Image size 1932x1910; 45-degree field of view — 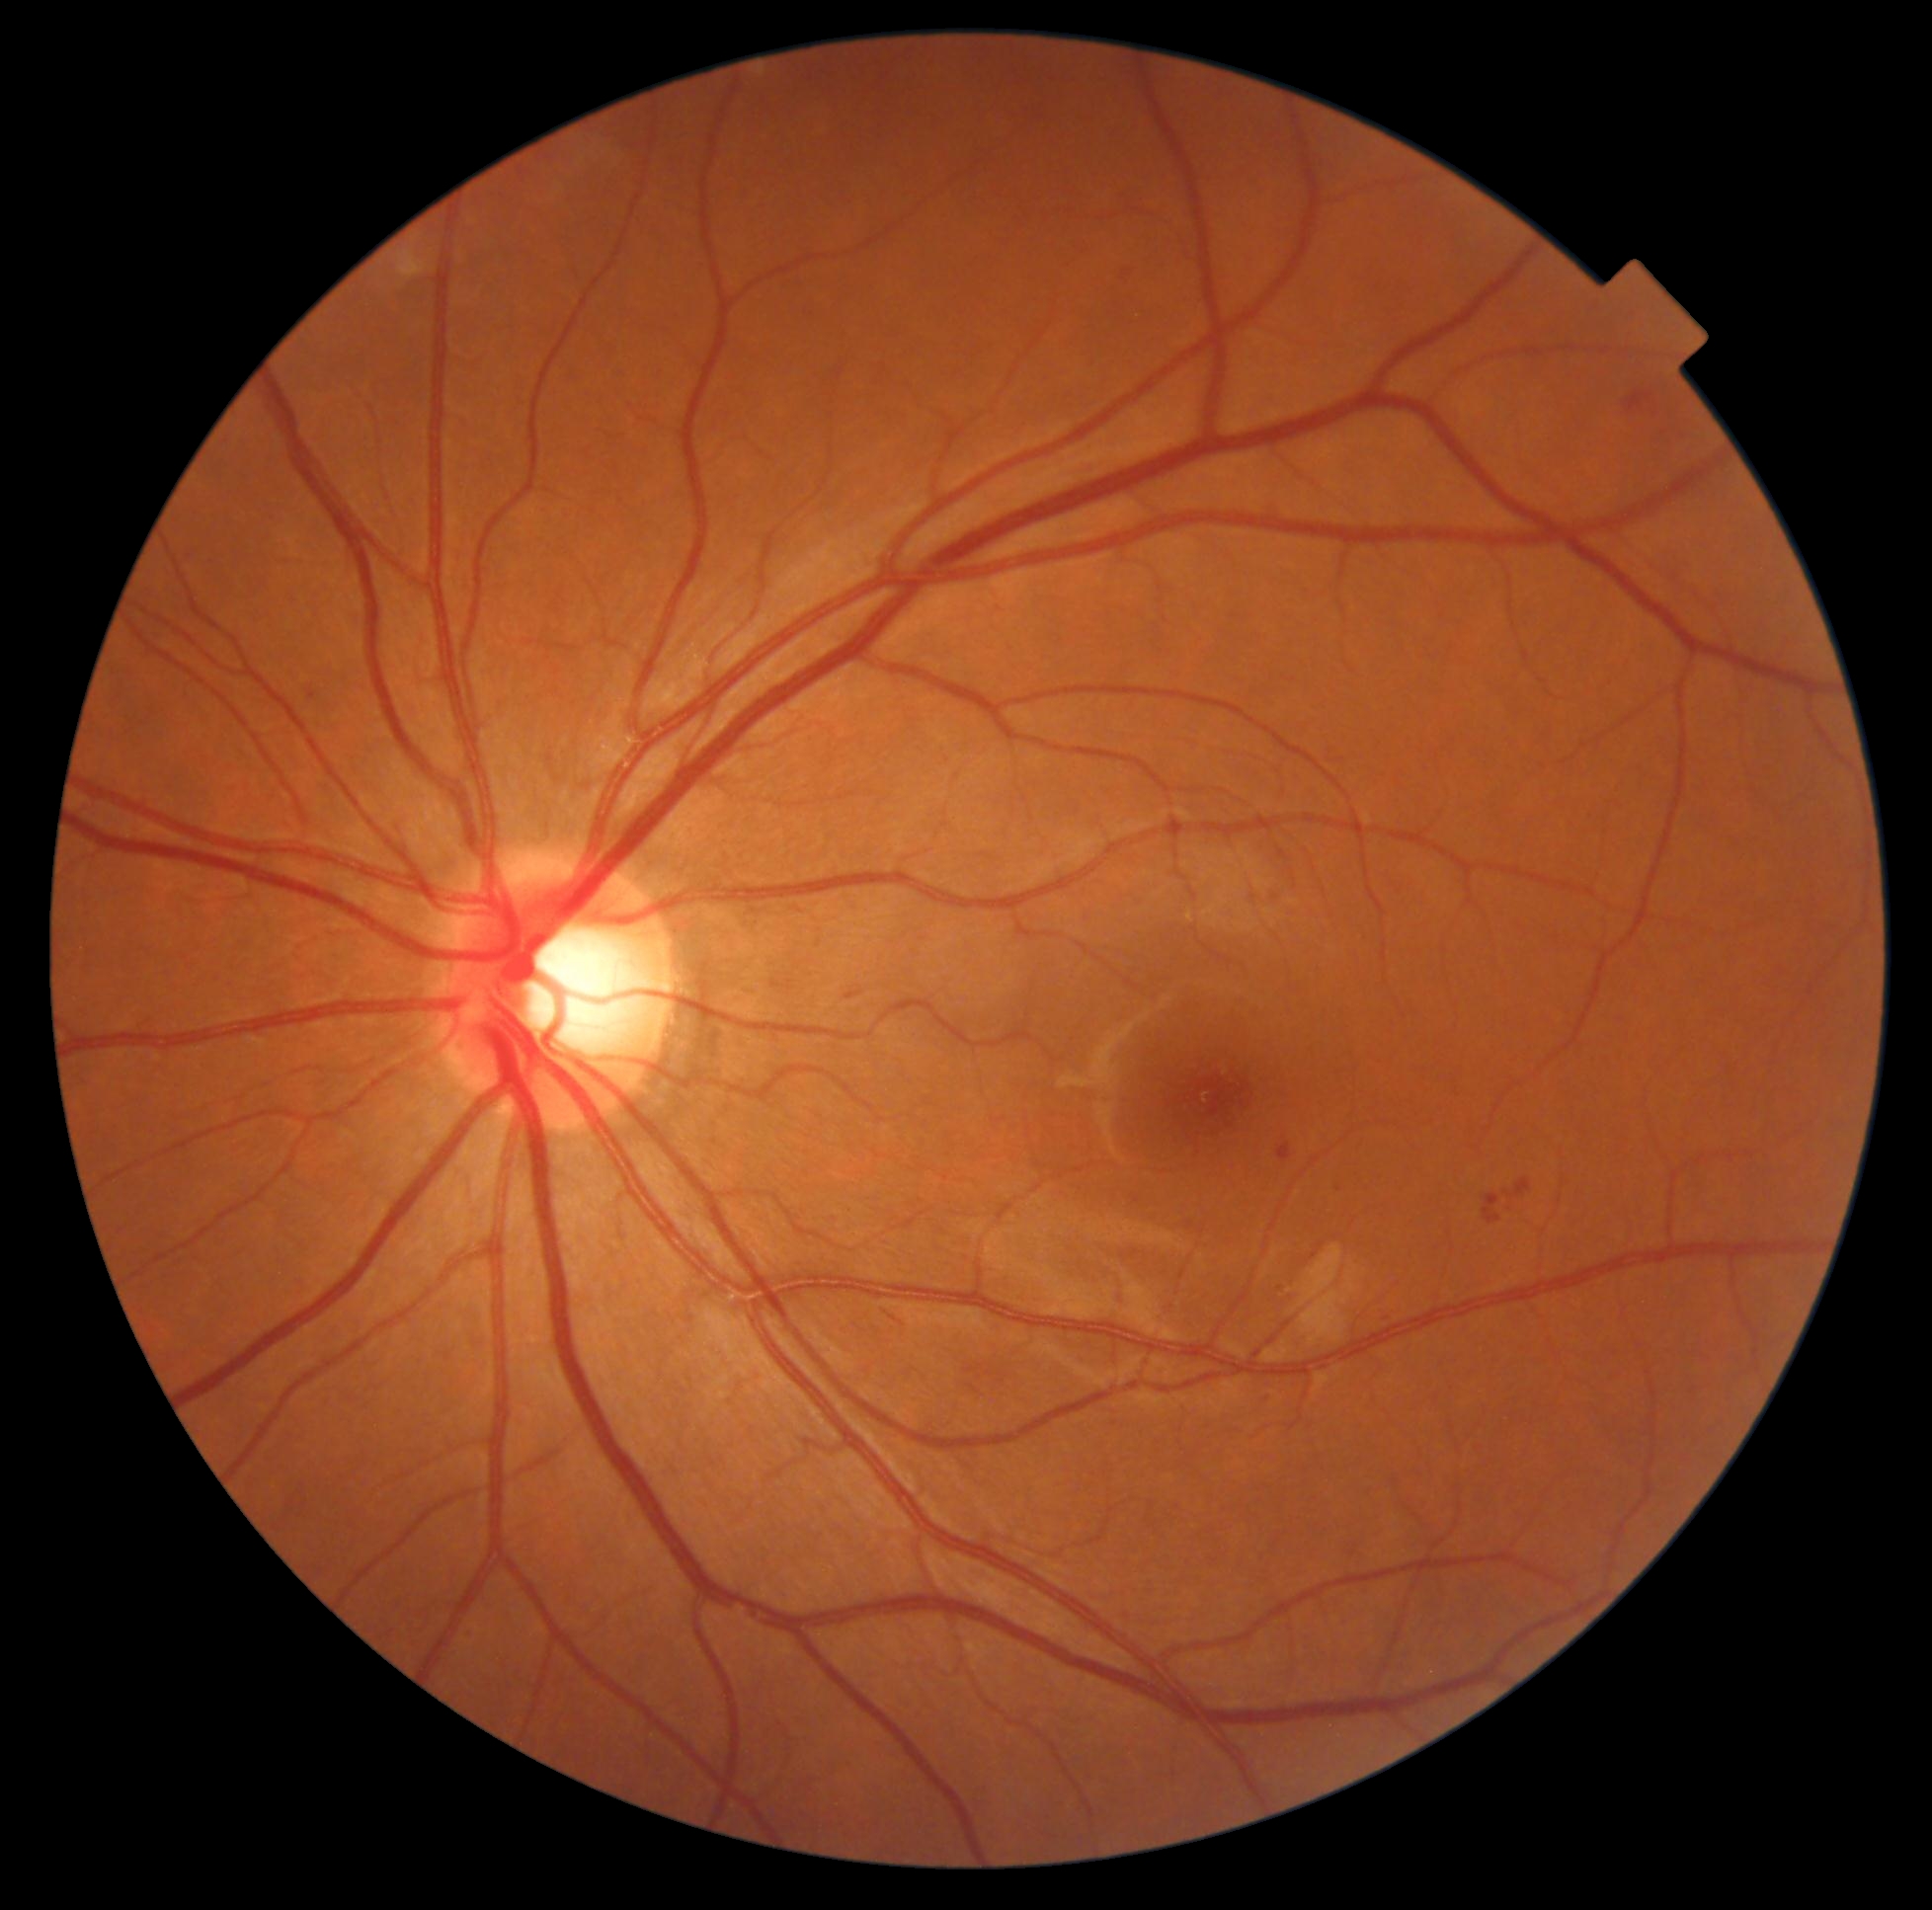

Diabetic retinopathy grade: 2 (moderate NPDR). DR class: non-proliferative diabetic retinopathy.